Color fundus photograph · 2212 x 1672 pixels: 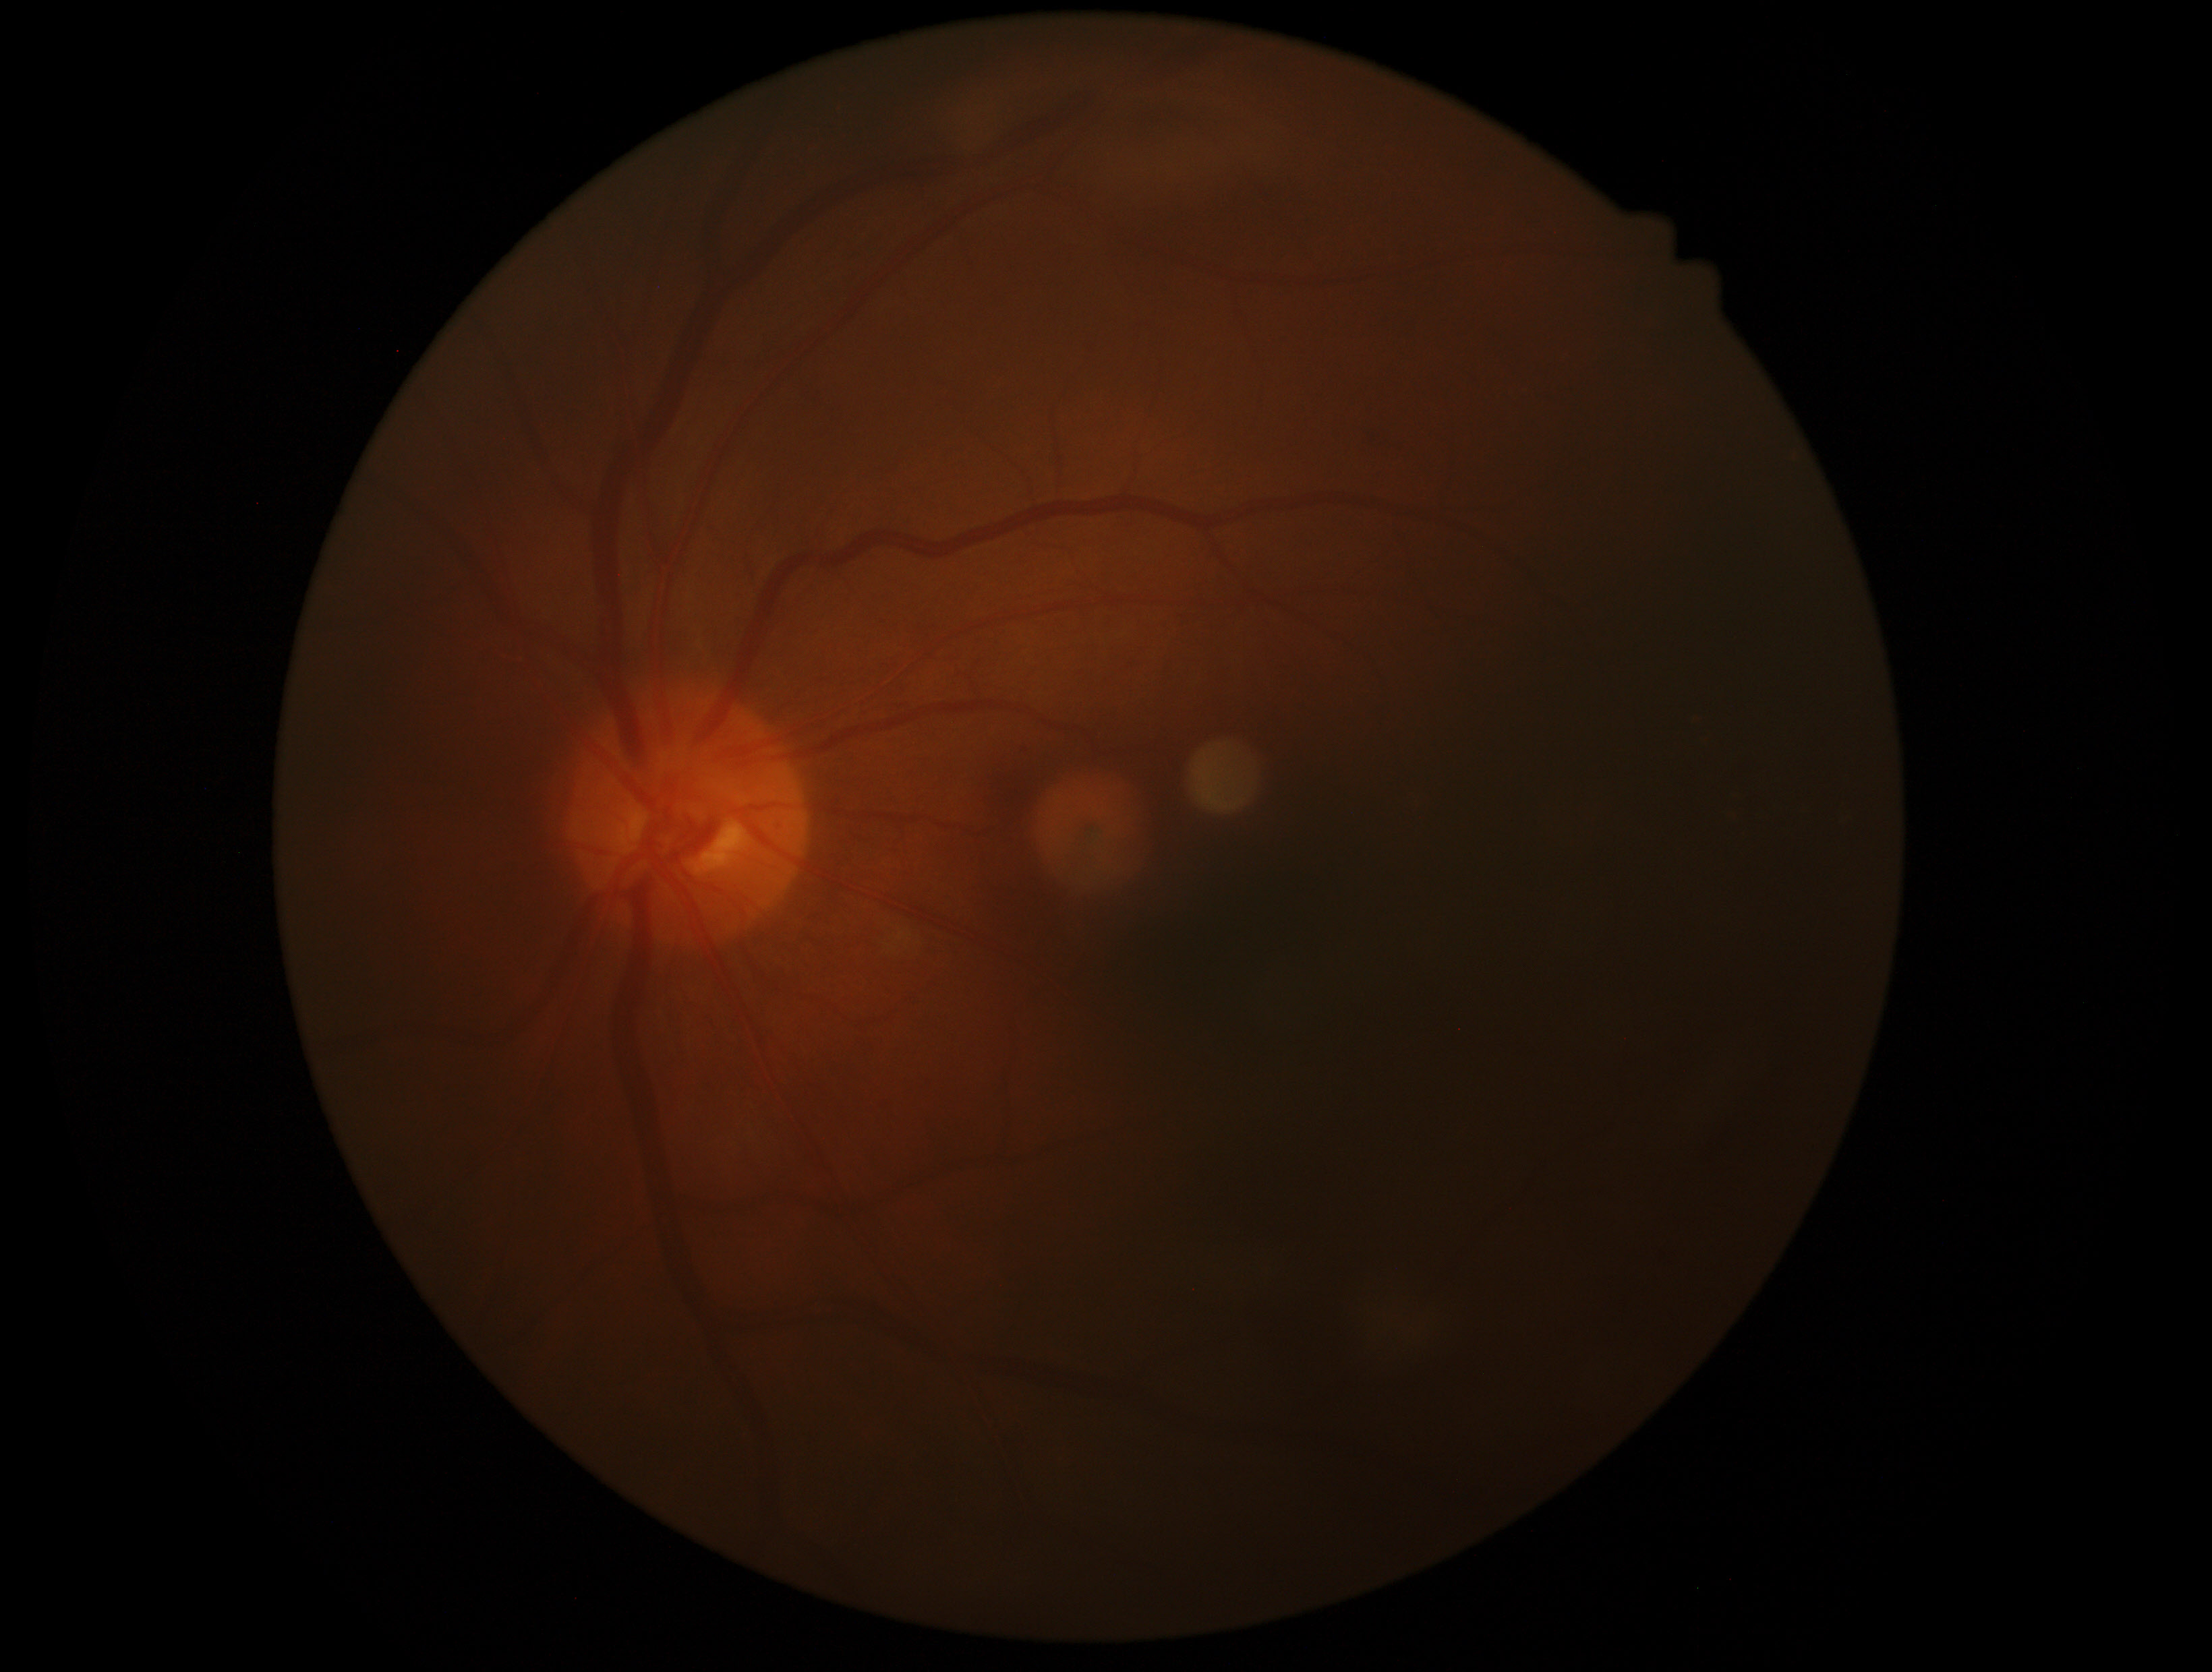 DR stage is no apparent diabetic retinopathy (grade 0).